Infant wide-field retinal image — 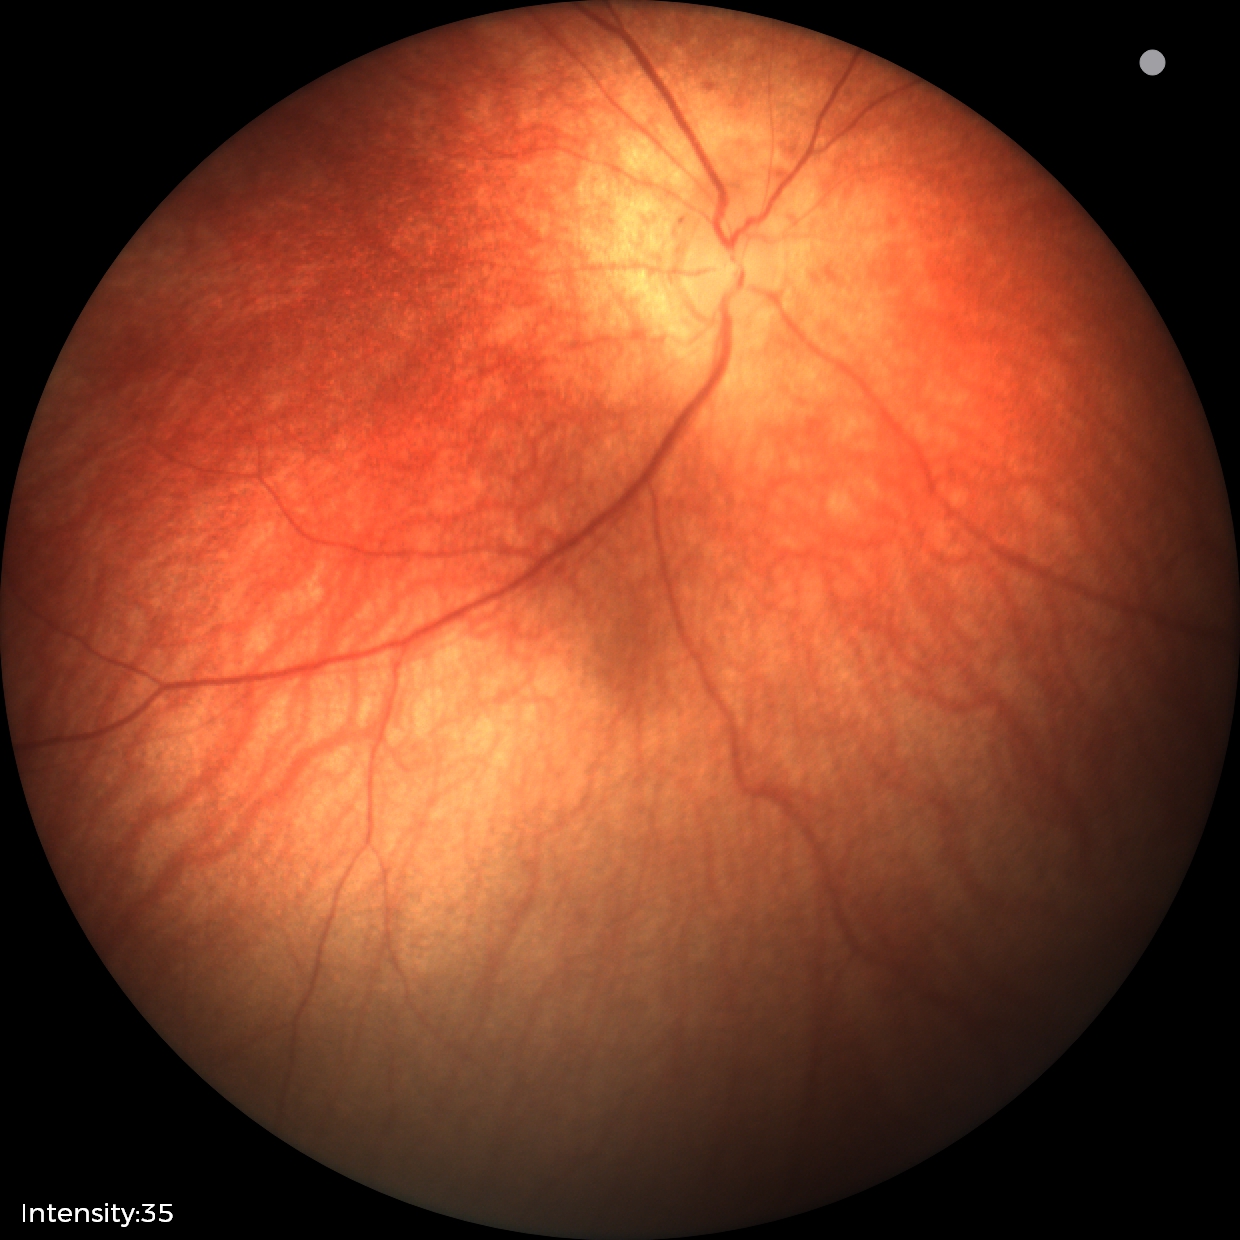
Impression = physiological.